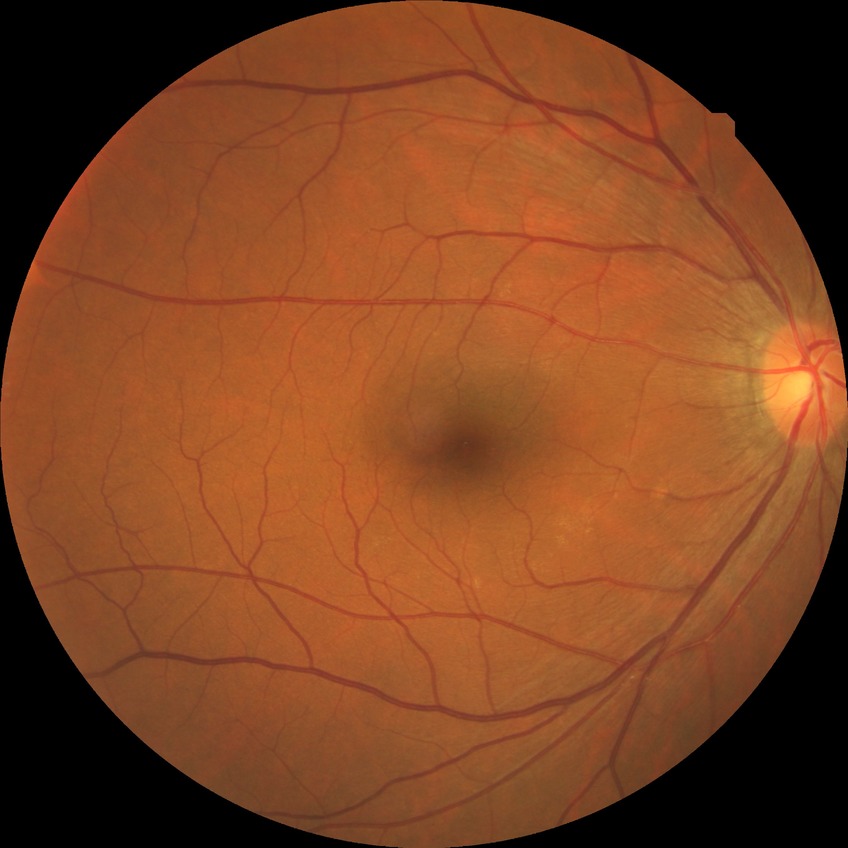 Retinopathy grade: no diabetic retinopathy.